Nonmydriatic fundus photograph. Diabetic retinopathy graded by the modified Davis classification:
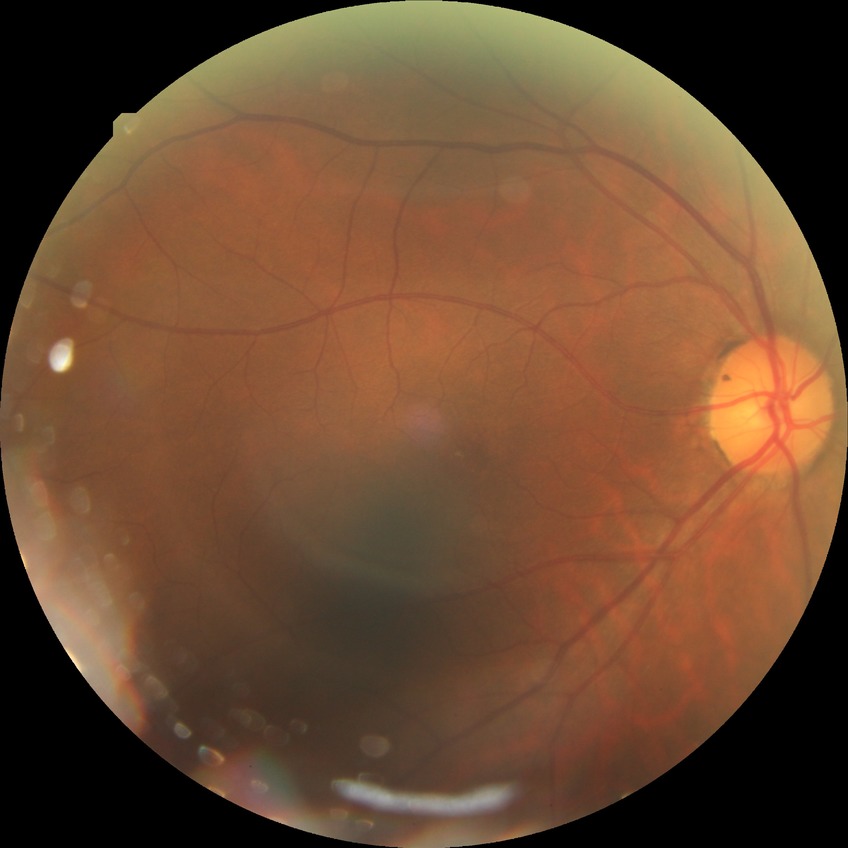
diabetic retinopathy (DR): no diabetic retinopathy (NDR).